Pediatric retinal photograph (wide-field) · captured with the Natus RetCam Envision (130° field of view).
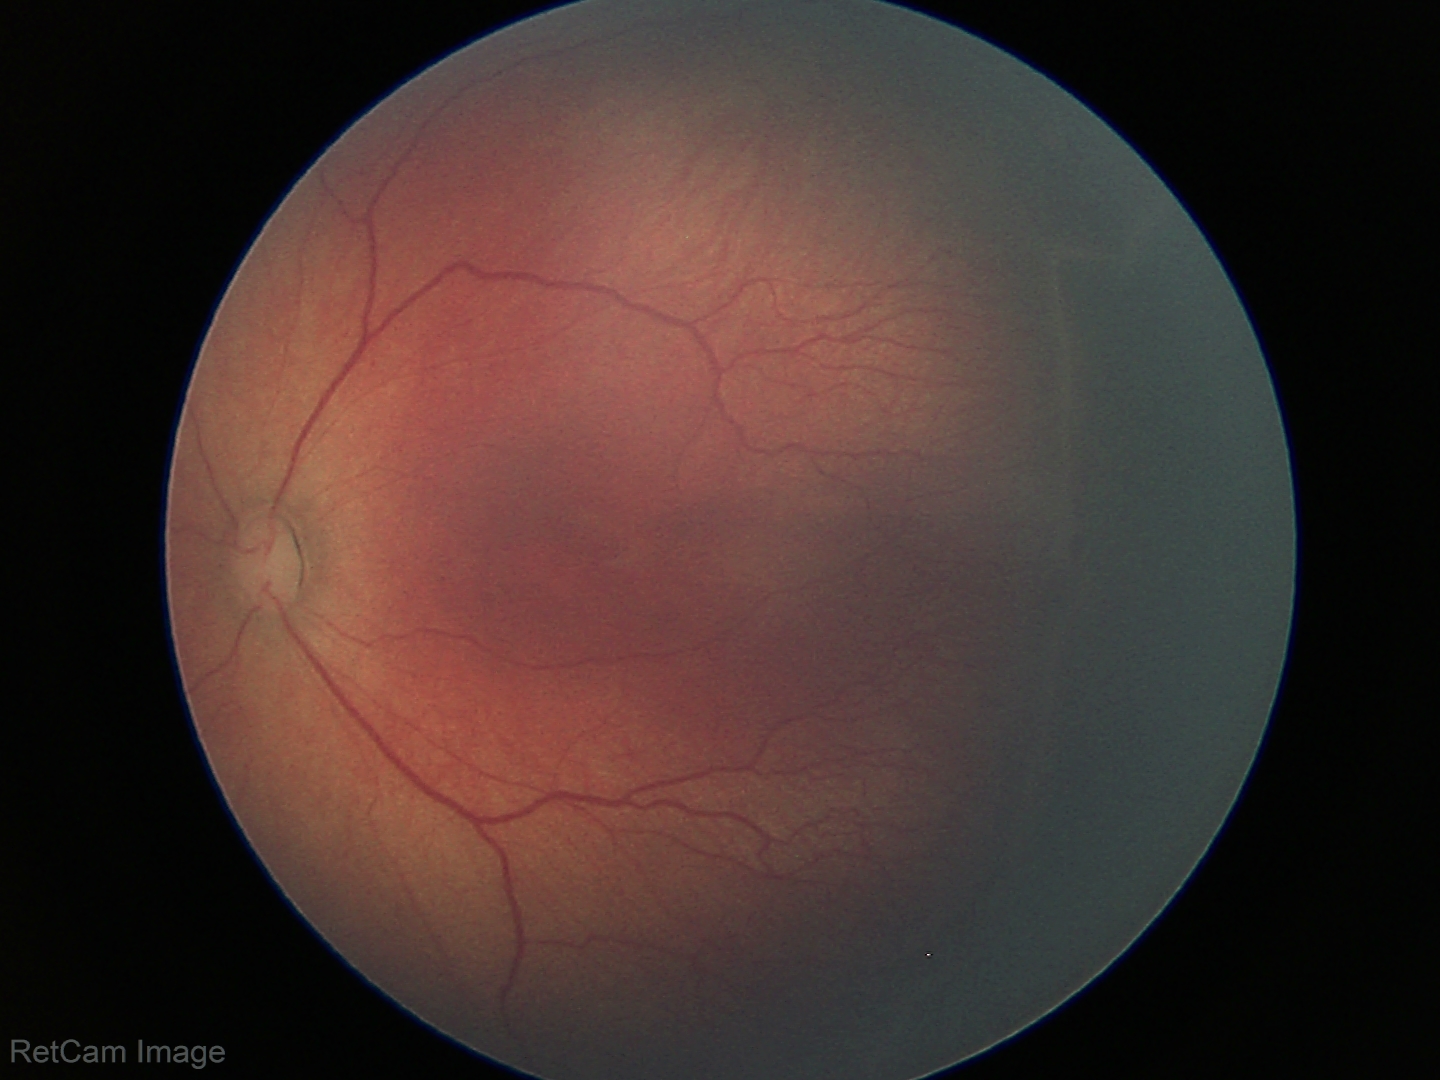 Plus form = absent; screening diagnosis = retinopathy of prematurity (ROP) stage 2.